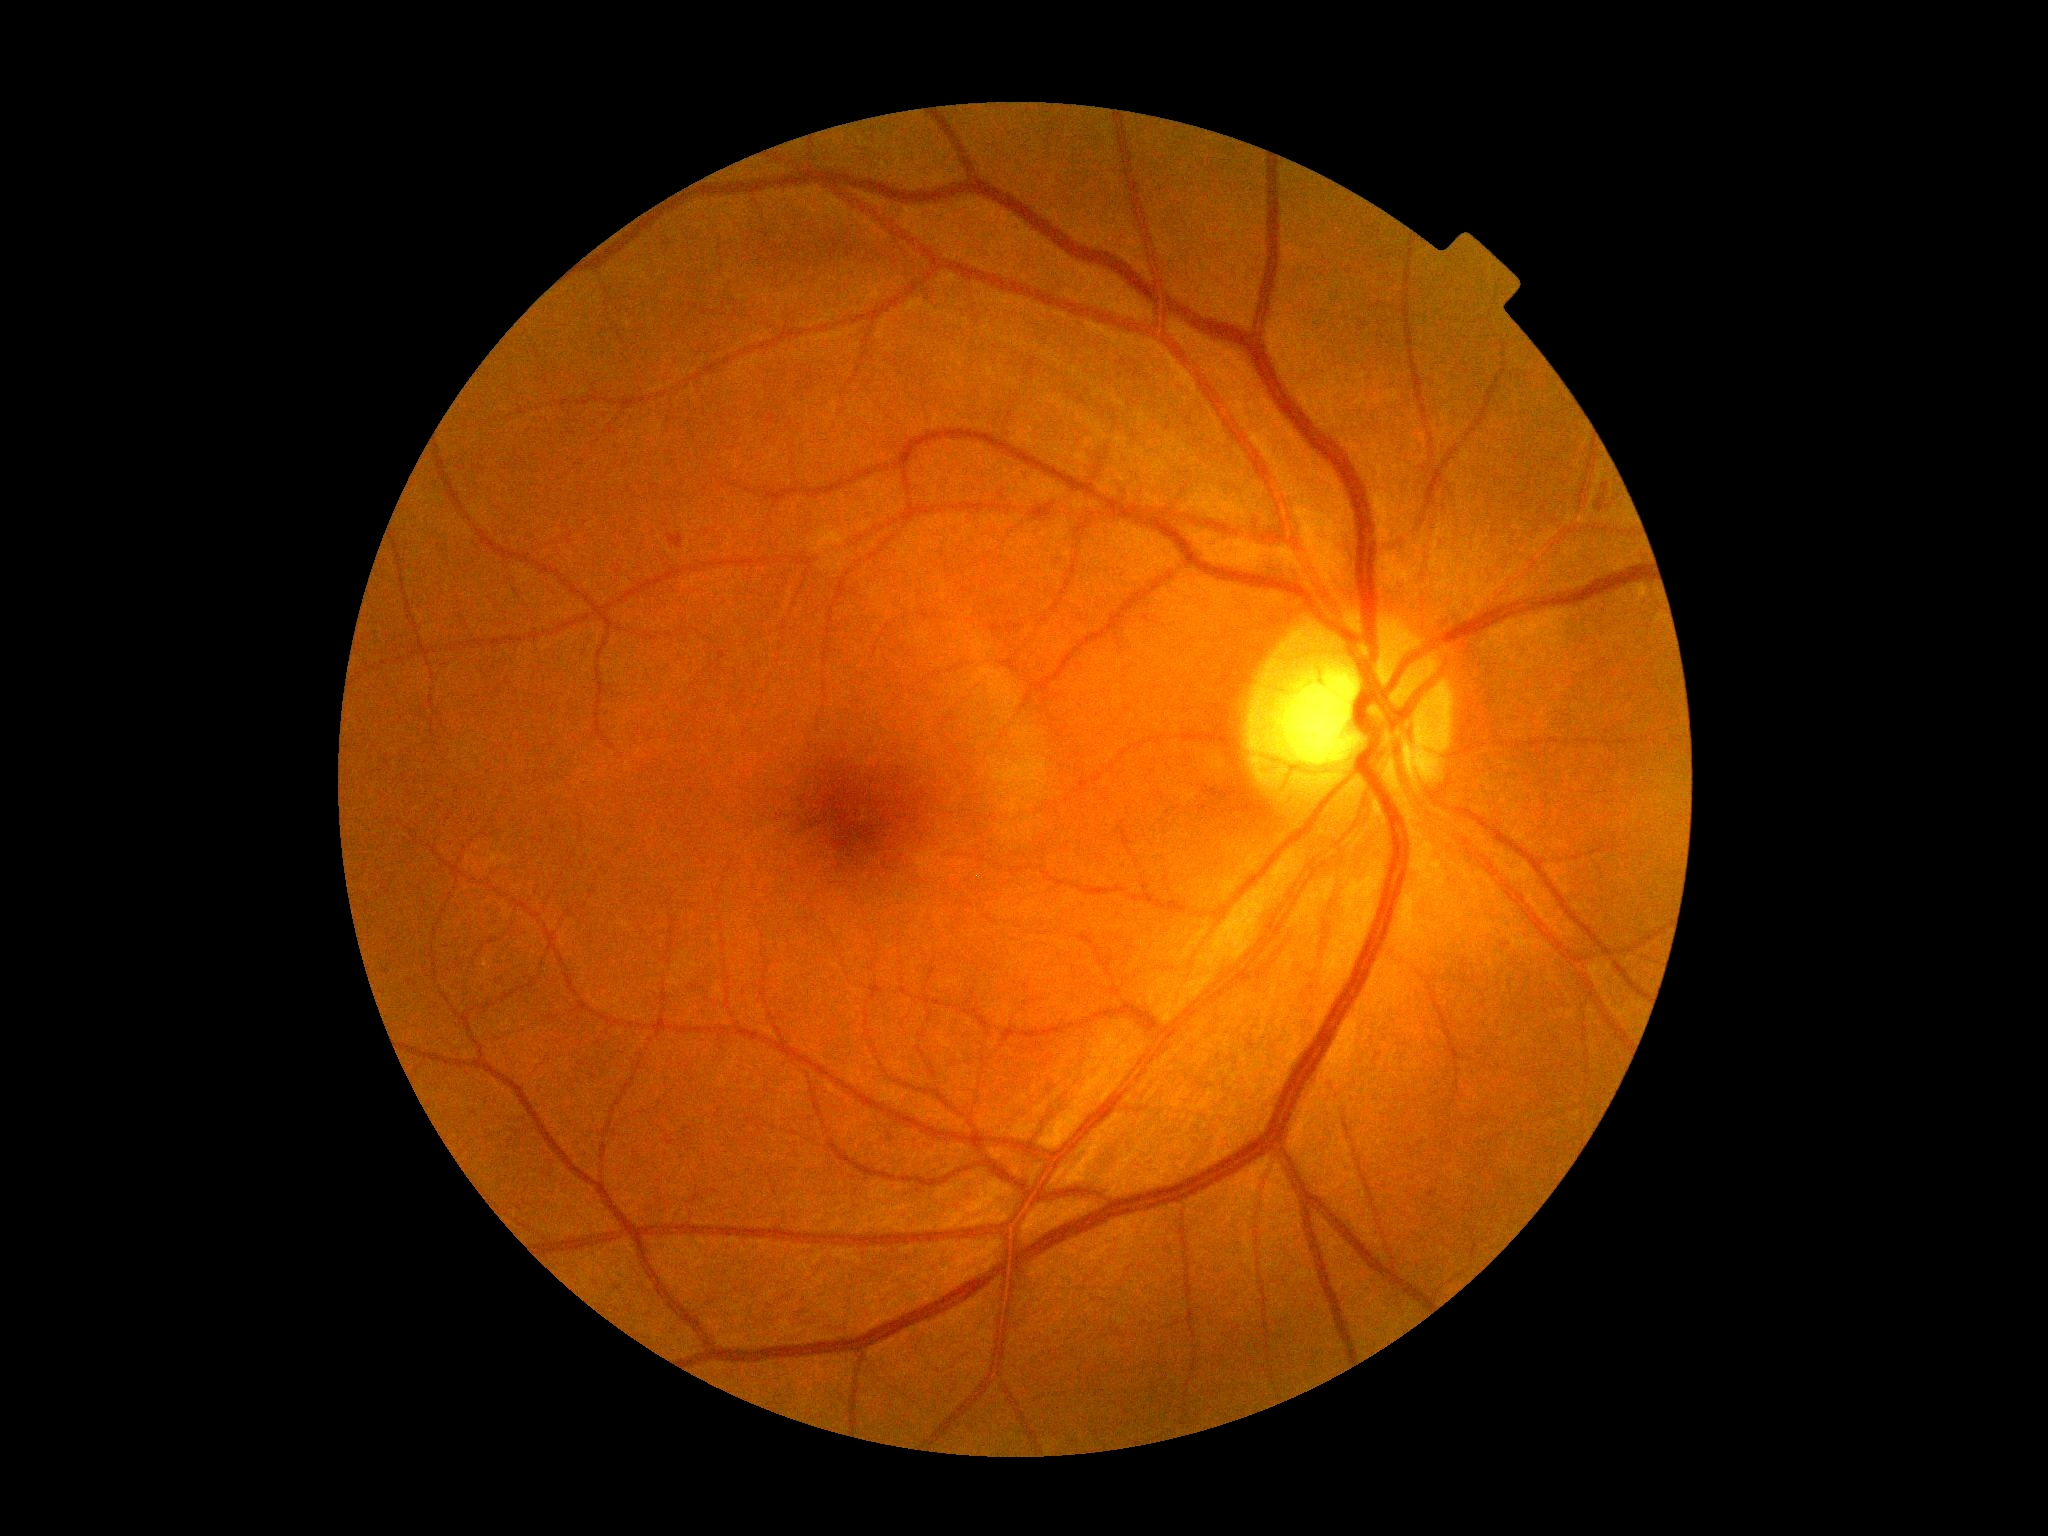 Retinopathy grade: 2 (moderate NPDR).